1440x1080 · RetCam wide-field infant fundus image.
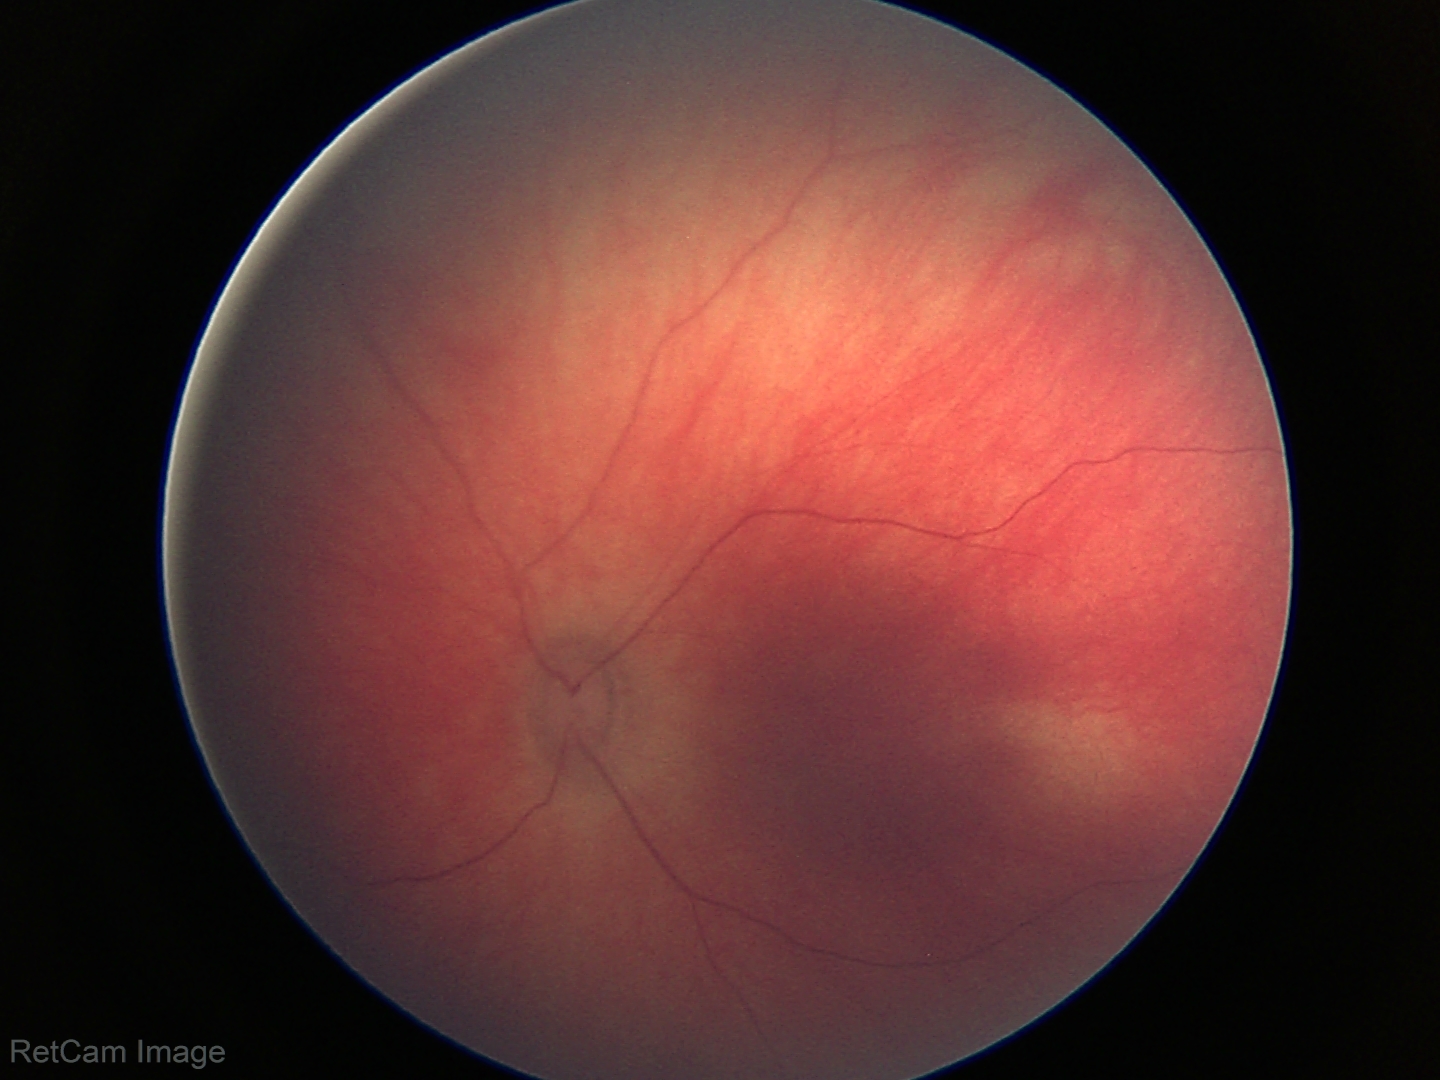
Screening examination with no abnormal retinal findings.